CFP · 45° field of view
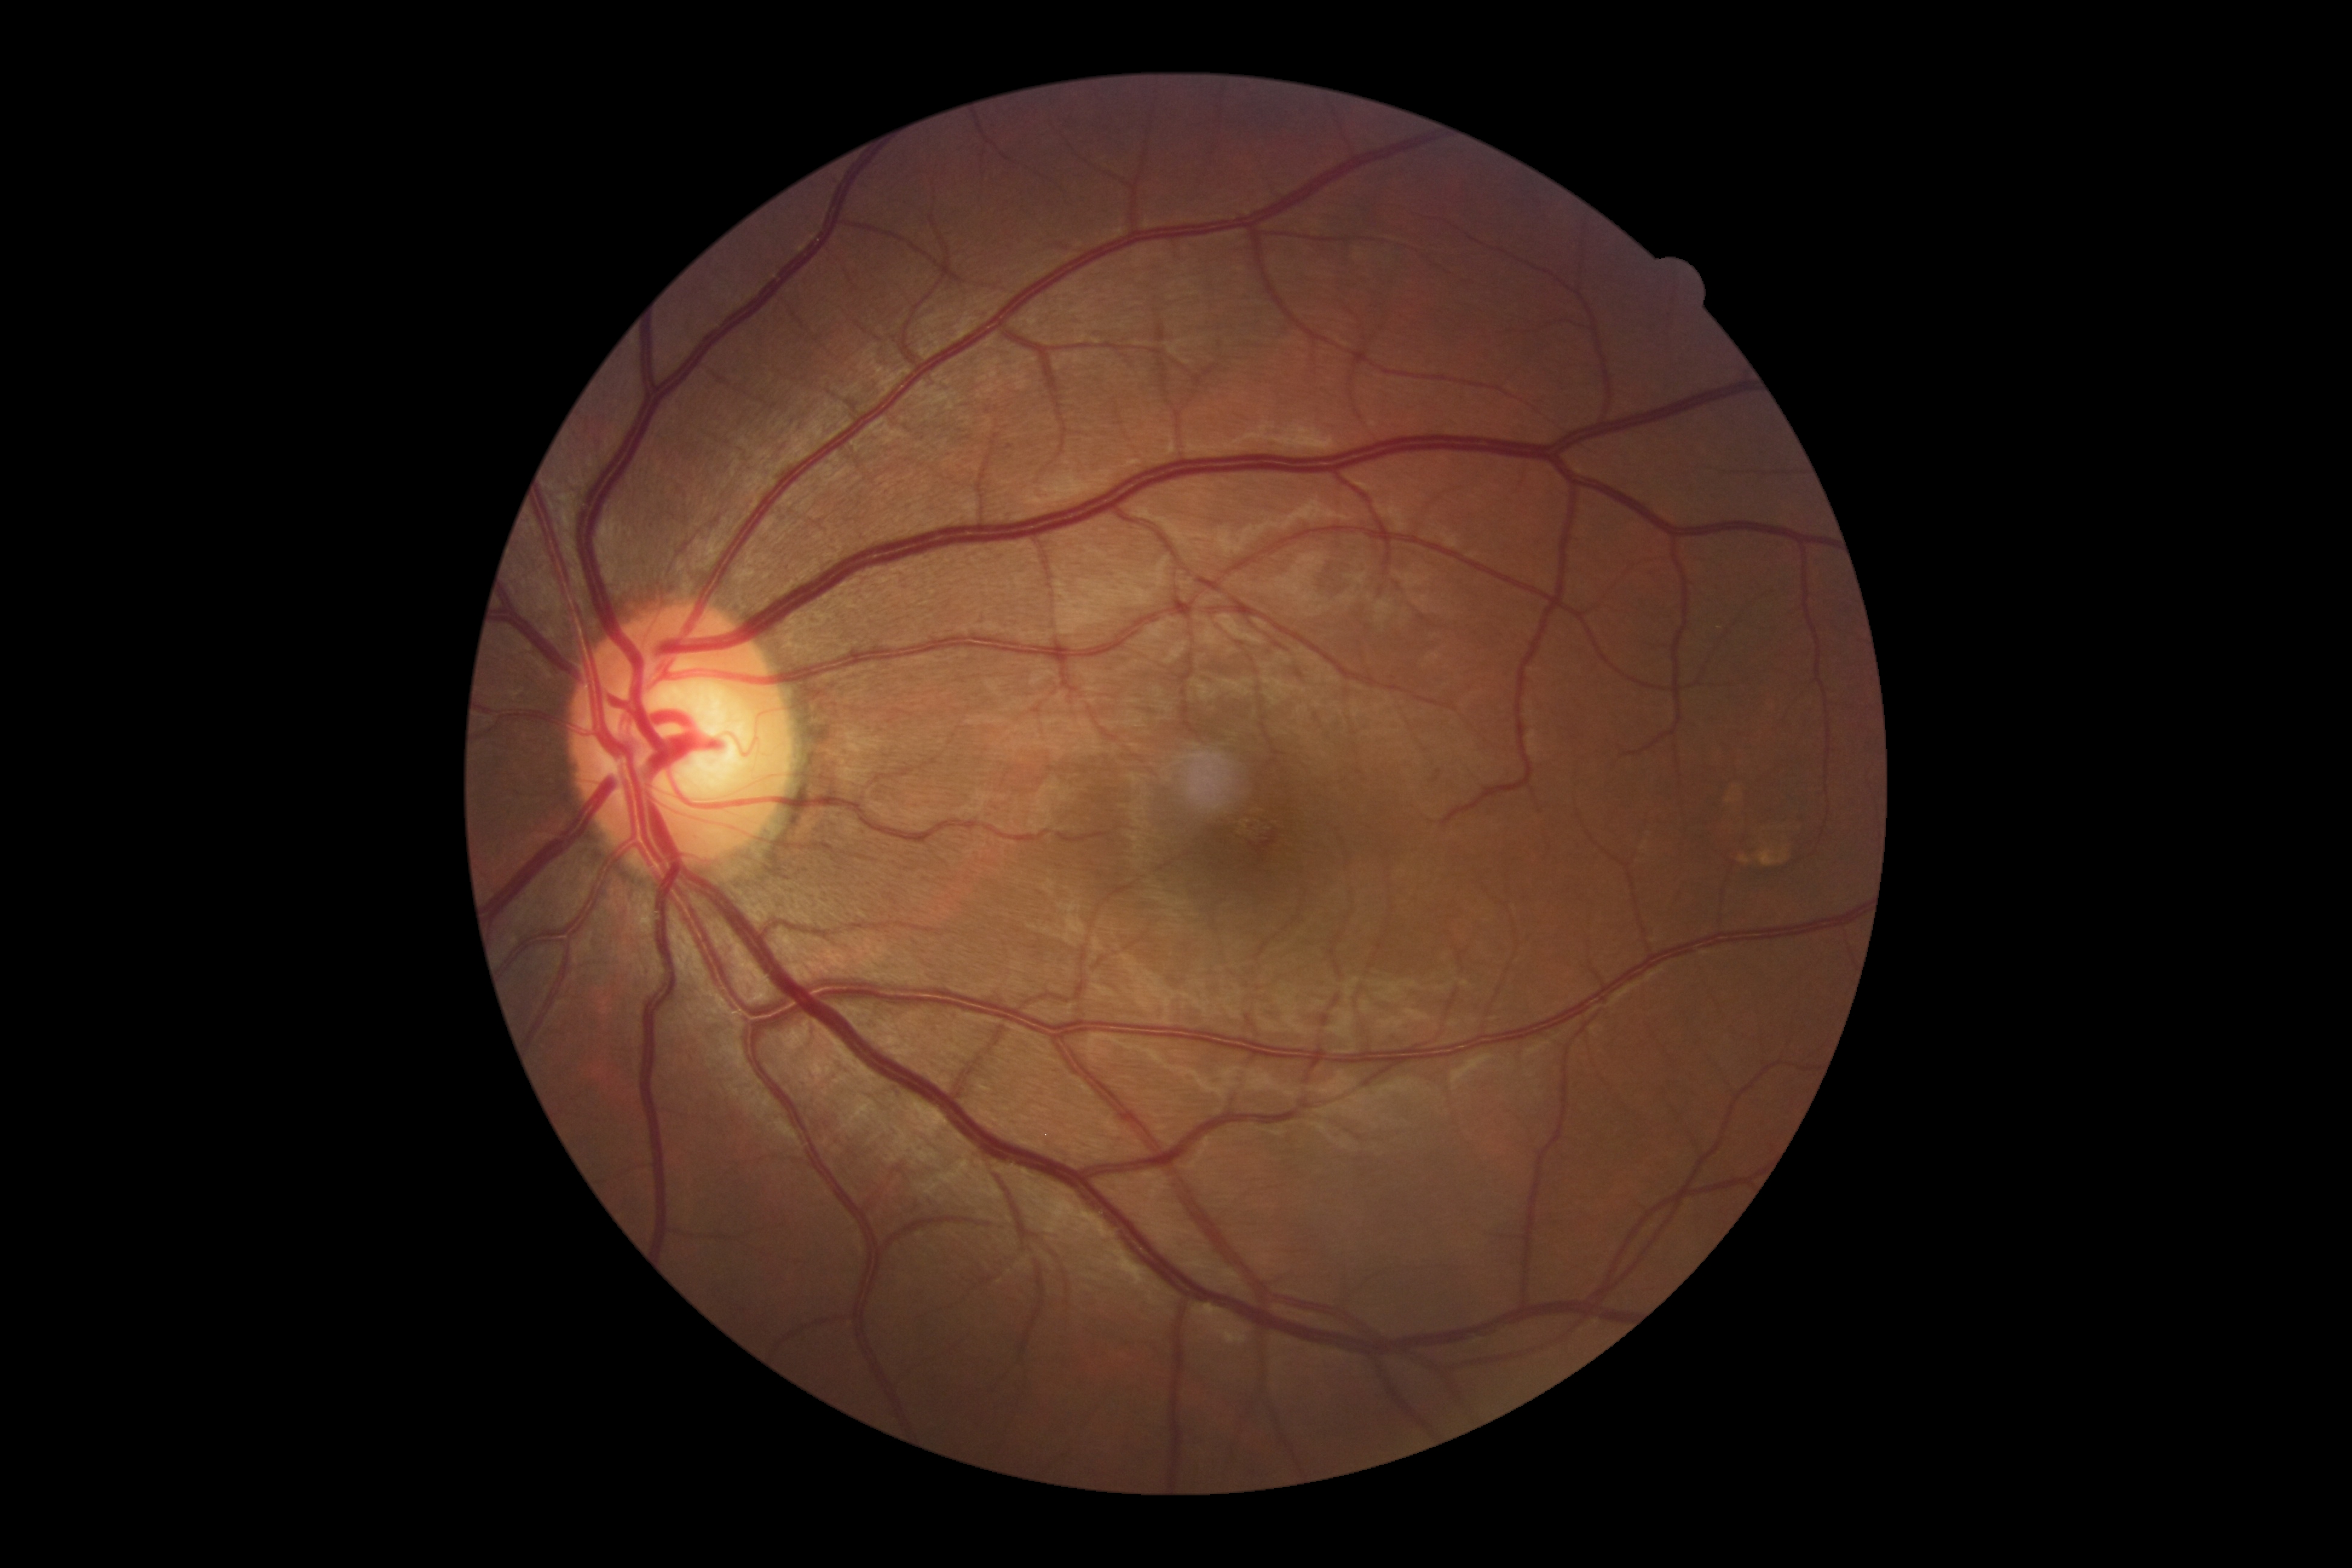 No DR findings. DR grade: 0 (no apparent retinopathy).